1240 by 1240 pixels. Wide-field fundus photograph of an infant: 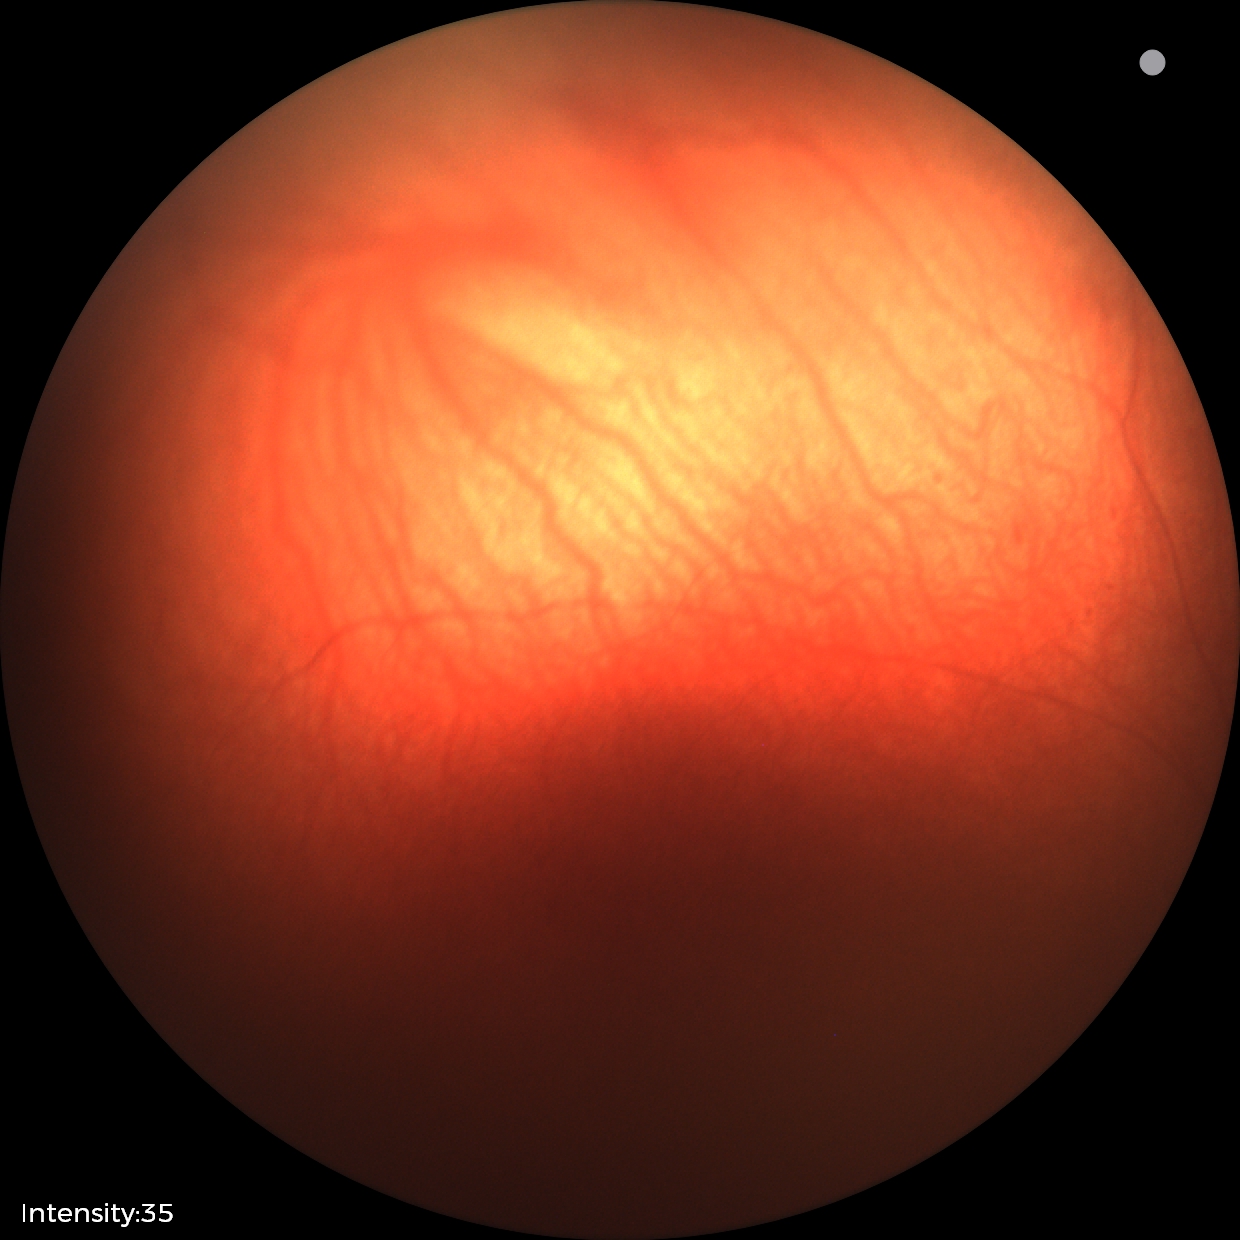

No retinal pathology identified on screening.